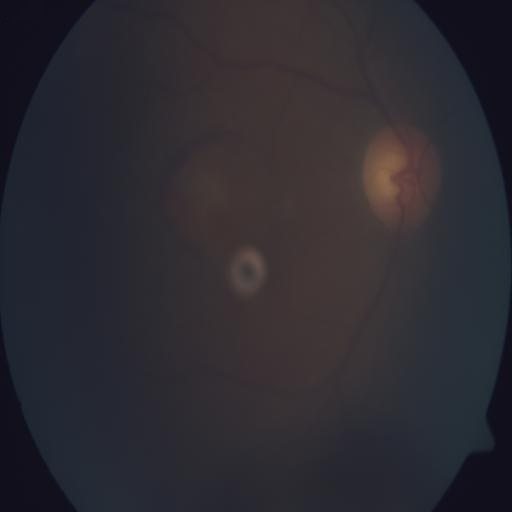

2 abnormalities. Findings consistent with media haze and macular scar.